Wide-field fundus photograph from neonatal ROP screening · 1240x1240:
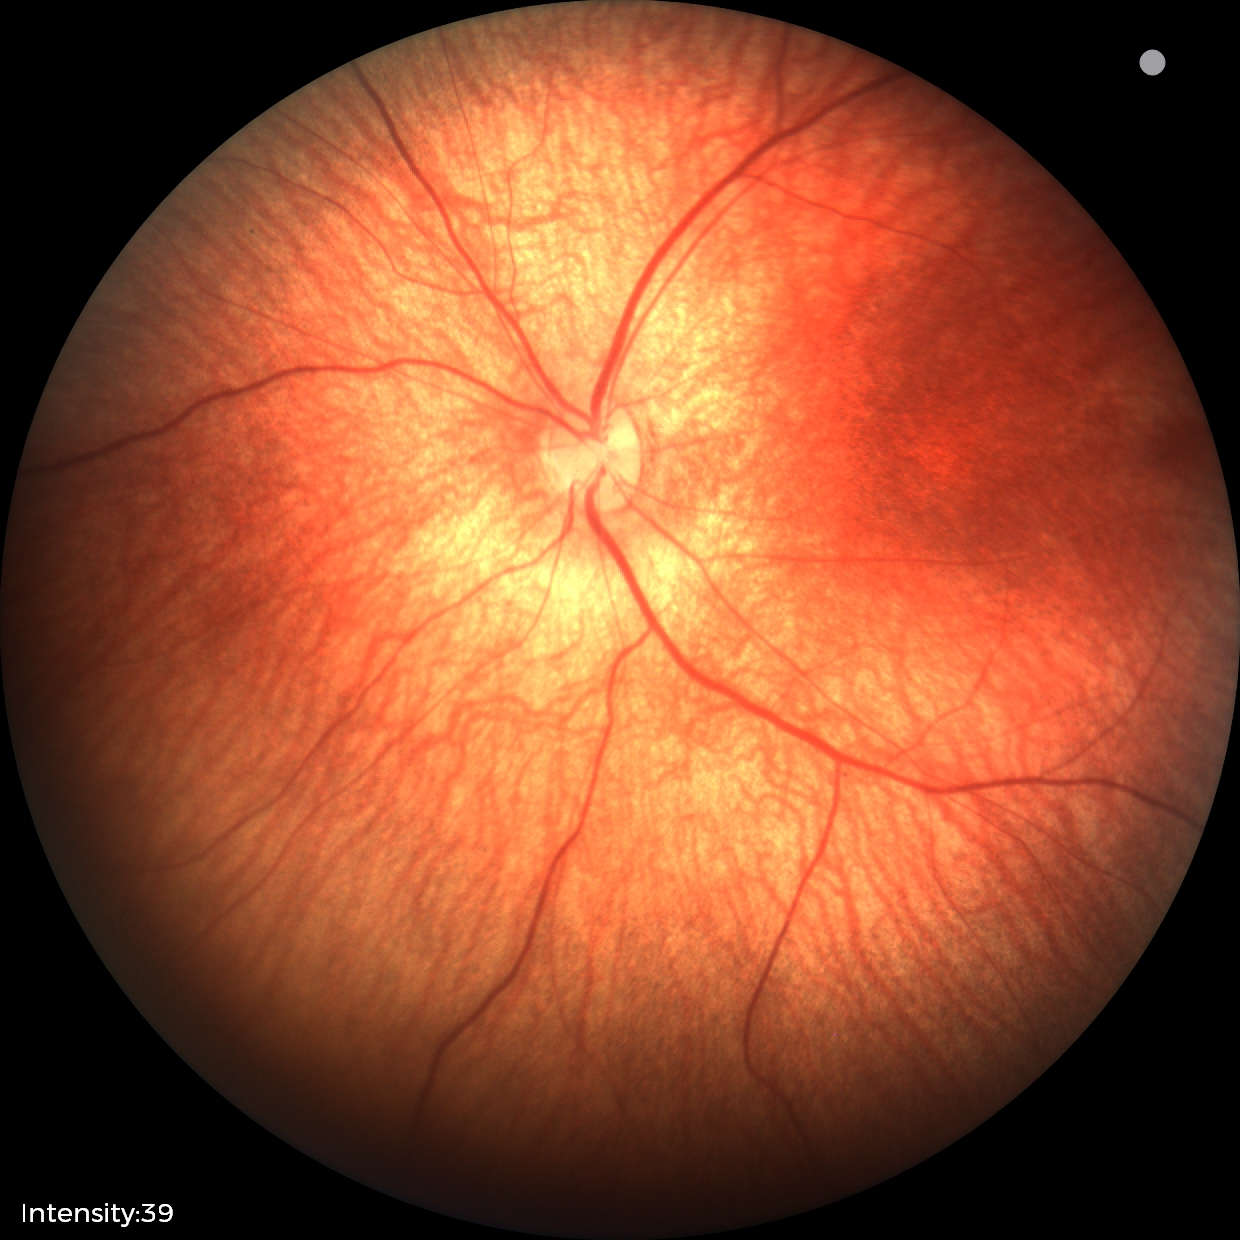
Screening examination consistent with retinal hemorrhages.